45-degree field of view. Image size 2048x1536. CFP
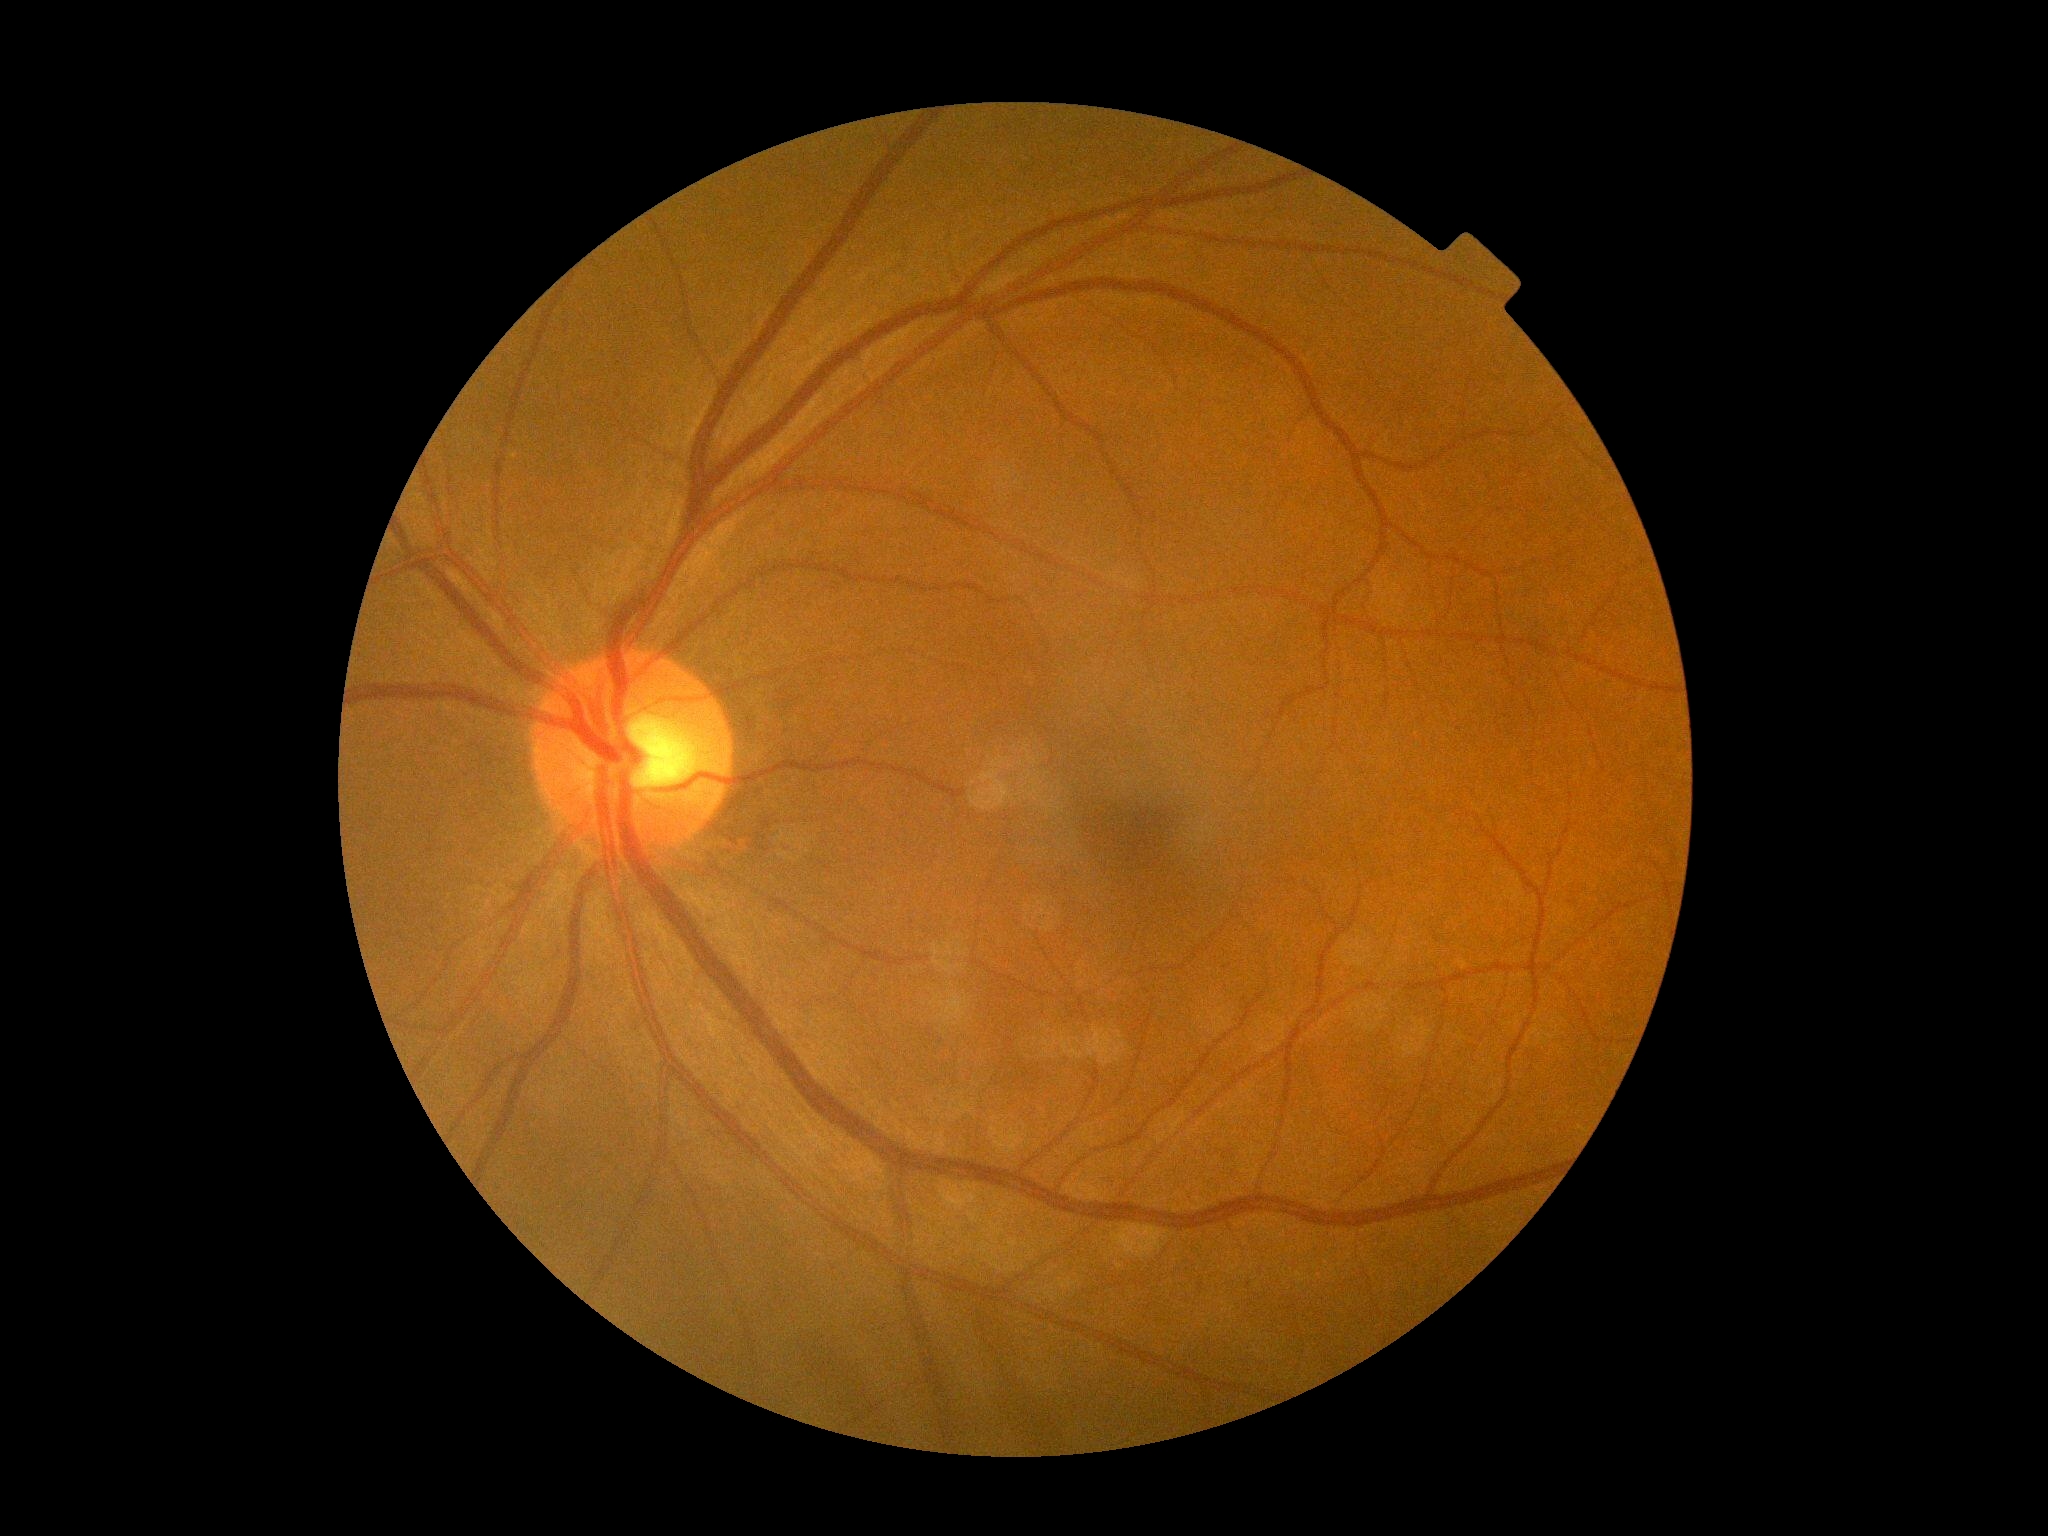

DR grade: 0 (no apparent retinopathy). No diabetic retinal disease findings.